240 by 240 pixels; optic disc region crop — 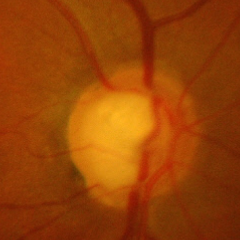 Q: Does this eye have glaucoma?
A: Yes — advanced glaucoma.